200° field of view, ultra-widefield fundus photograph: 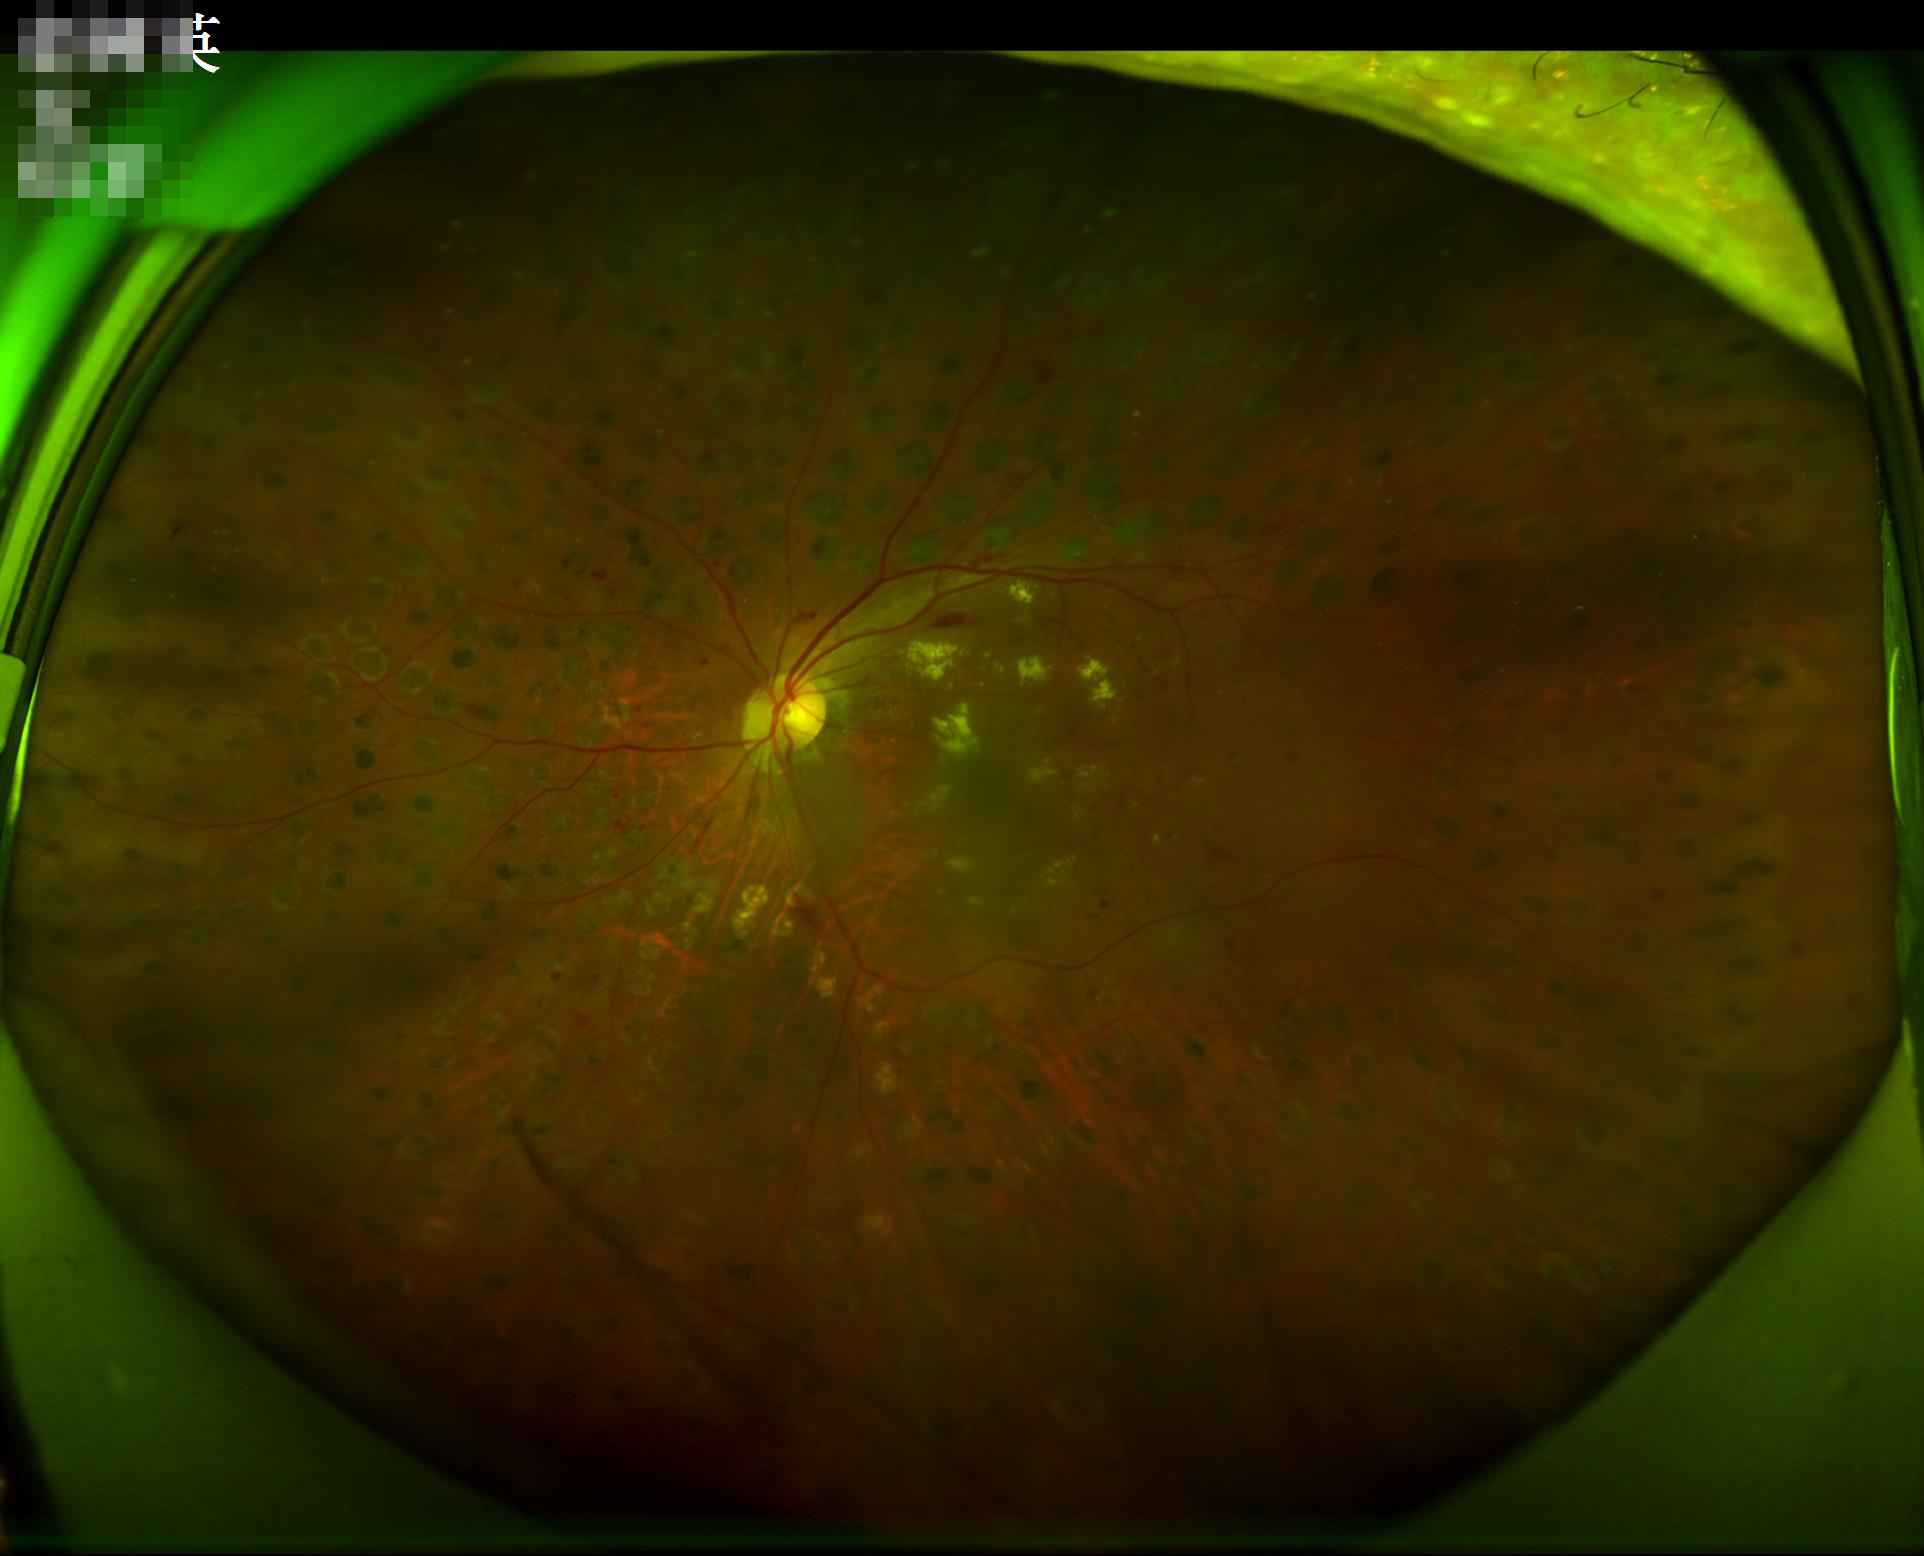
Image is sharp throughout the field. There is over- or under-exposure or a color cast. Acceptable image quality.